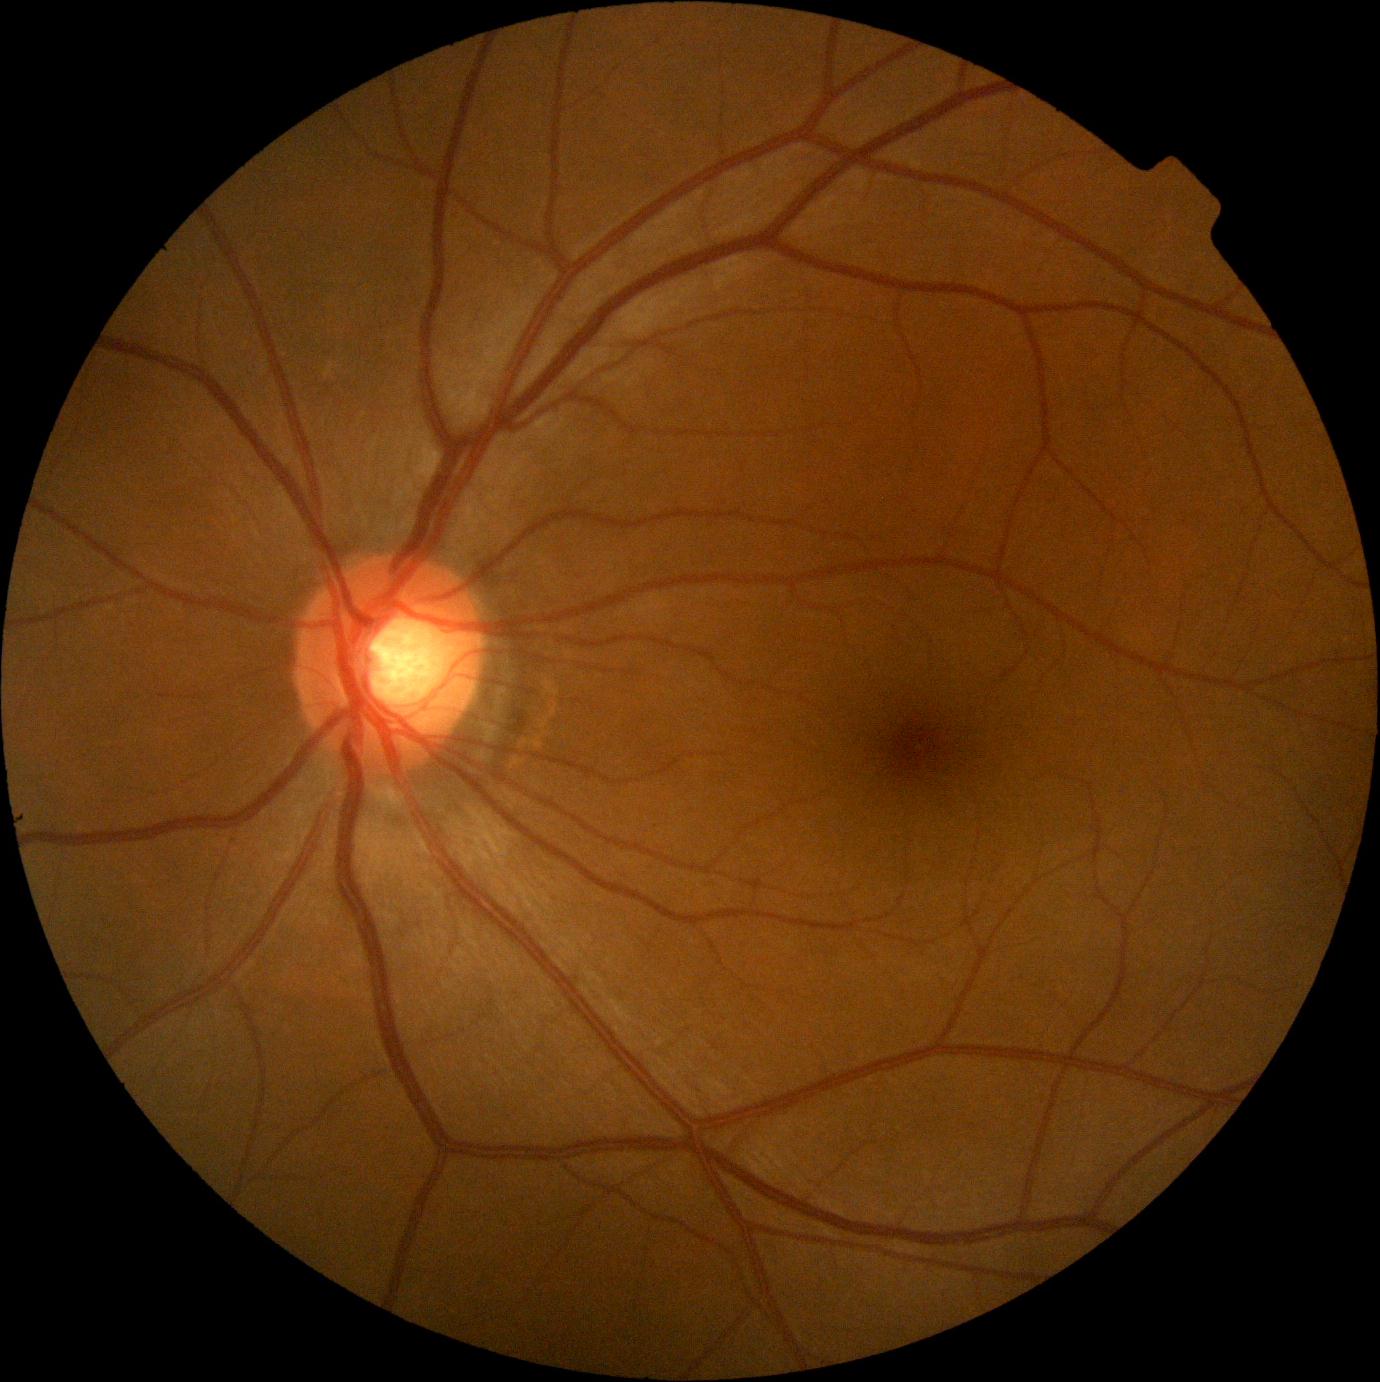
• DR grade: no apparent retinopathy (0) — no visible signs of diabetic retinopathy